Fundus photo.
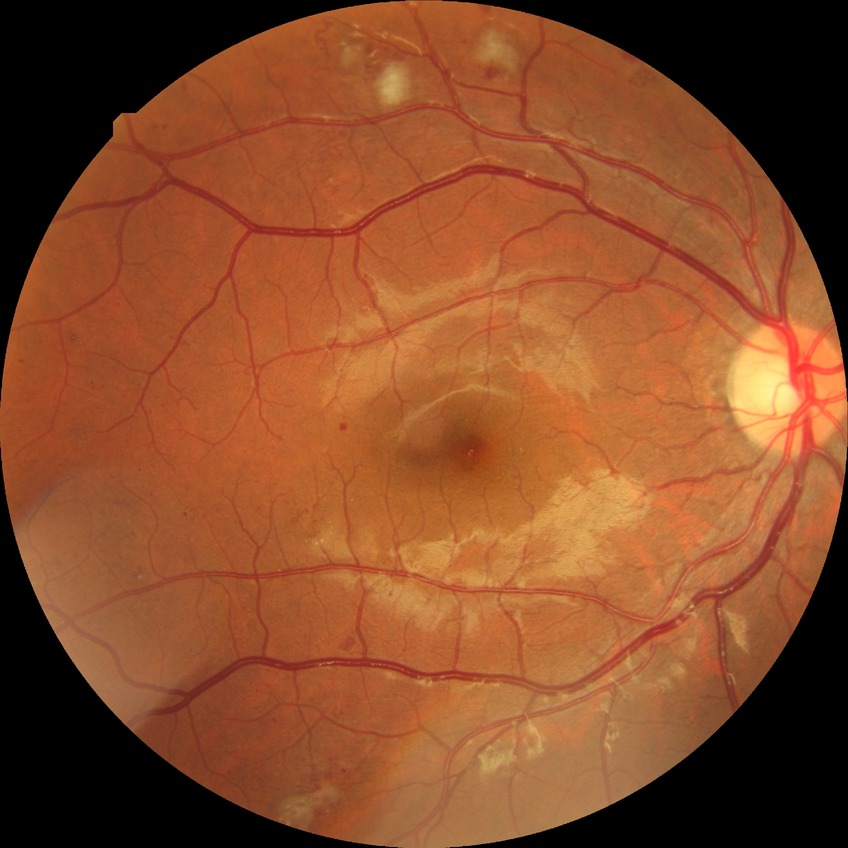 Retinopathy stage: pre-proliferative diabetic retinopathy.